Acquired with a NIDEK AFC-230 · no pharmacologic dilation — 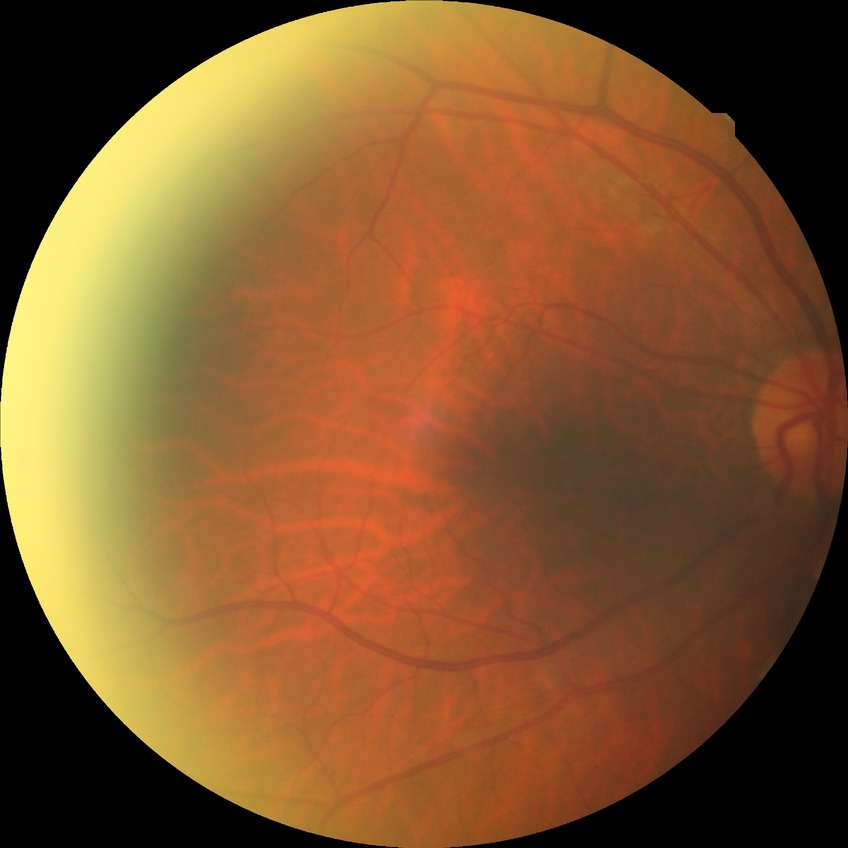

{
  "davis_grade": "NDR"
}